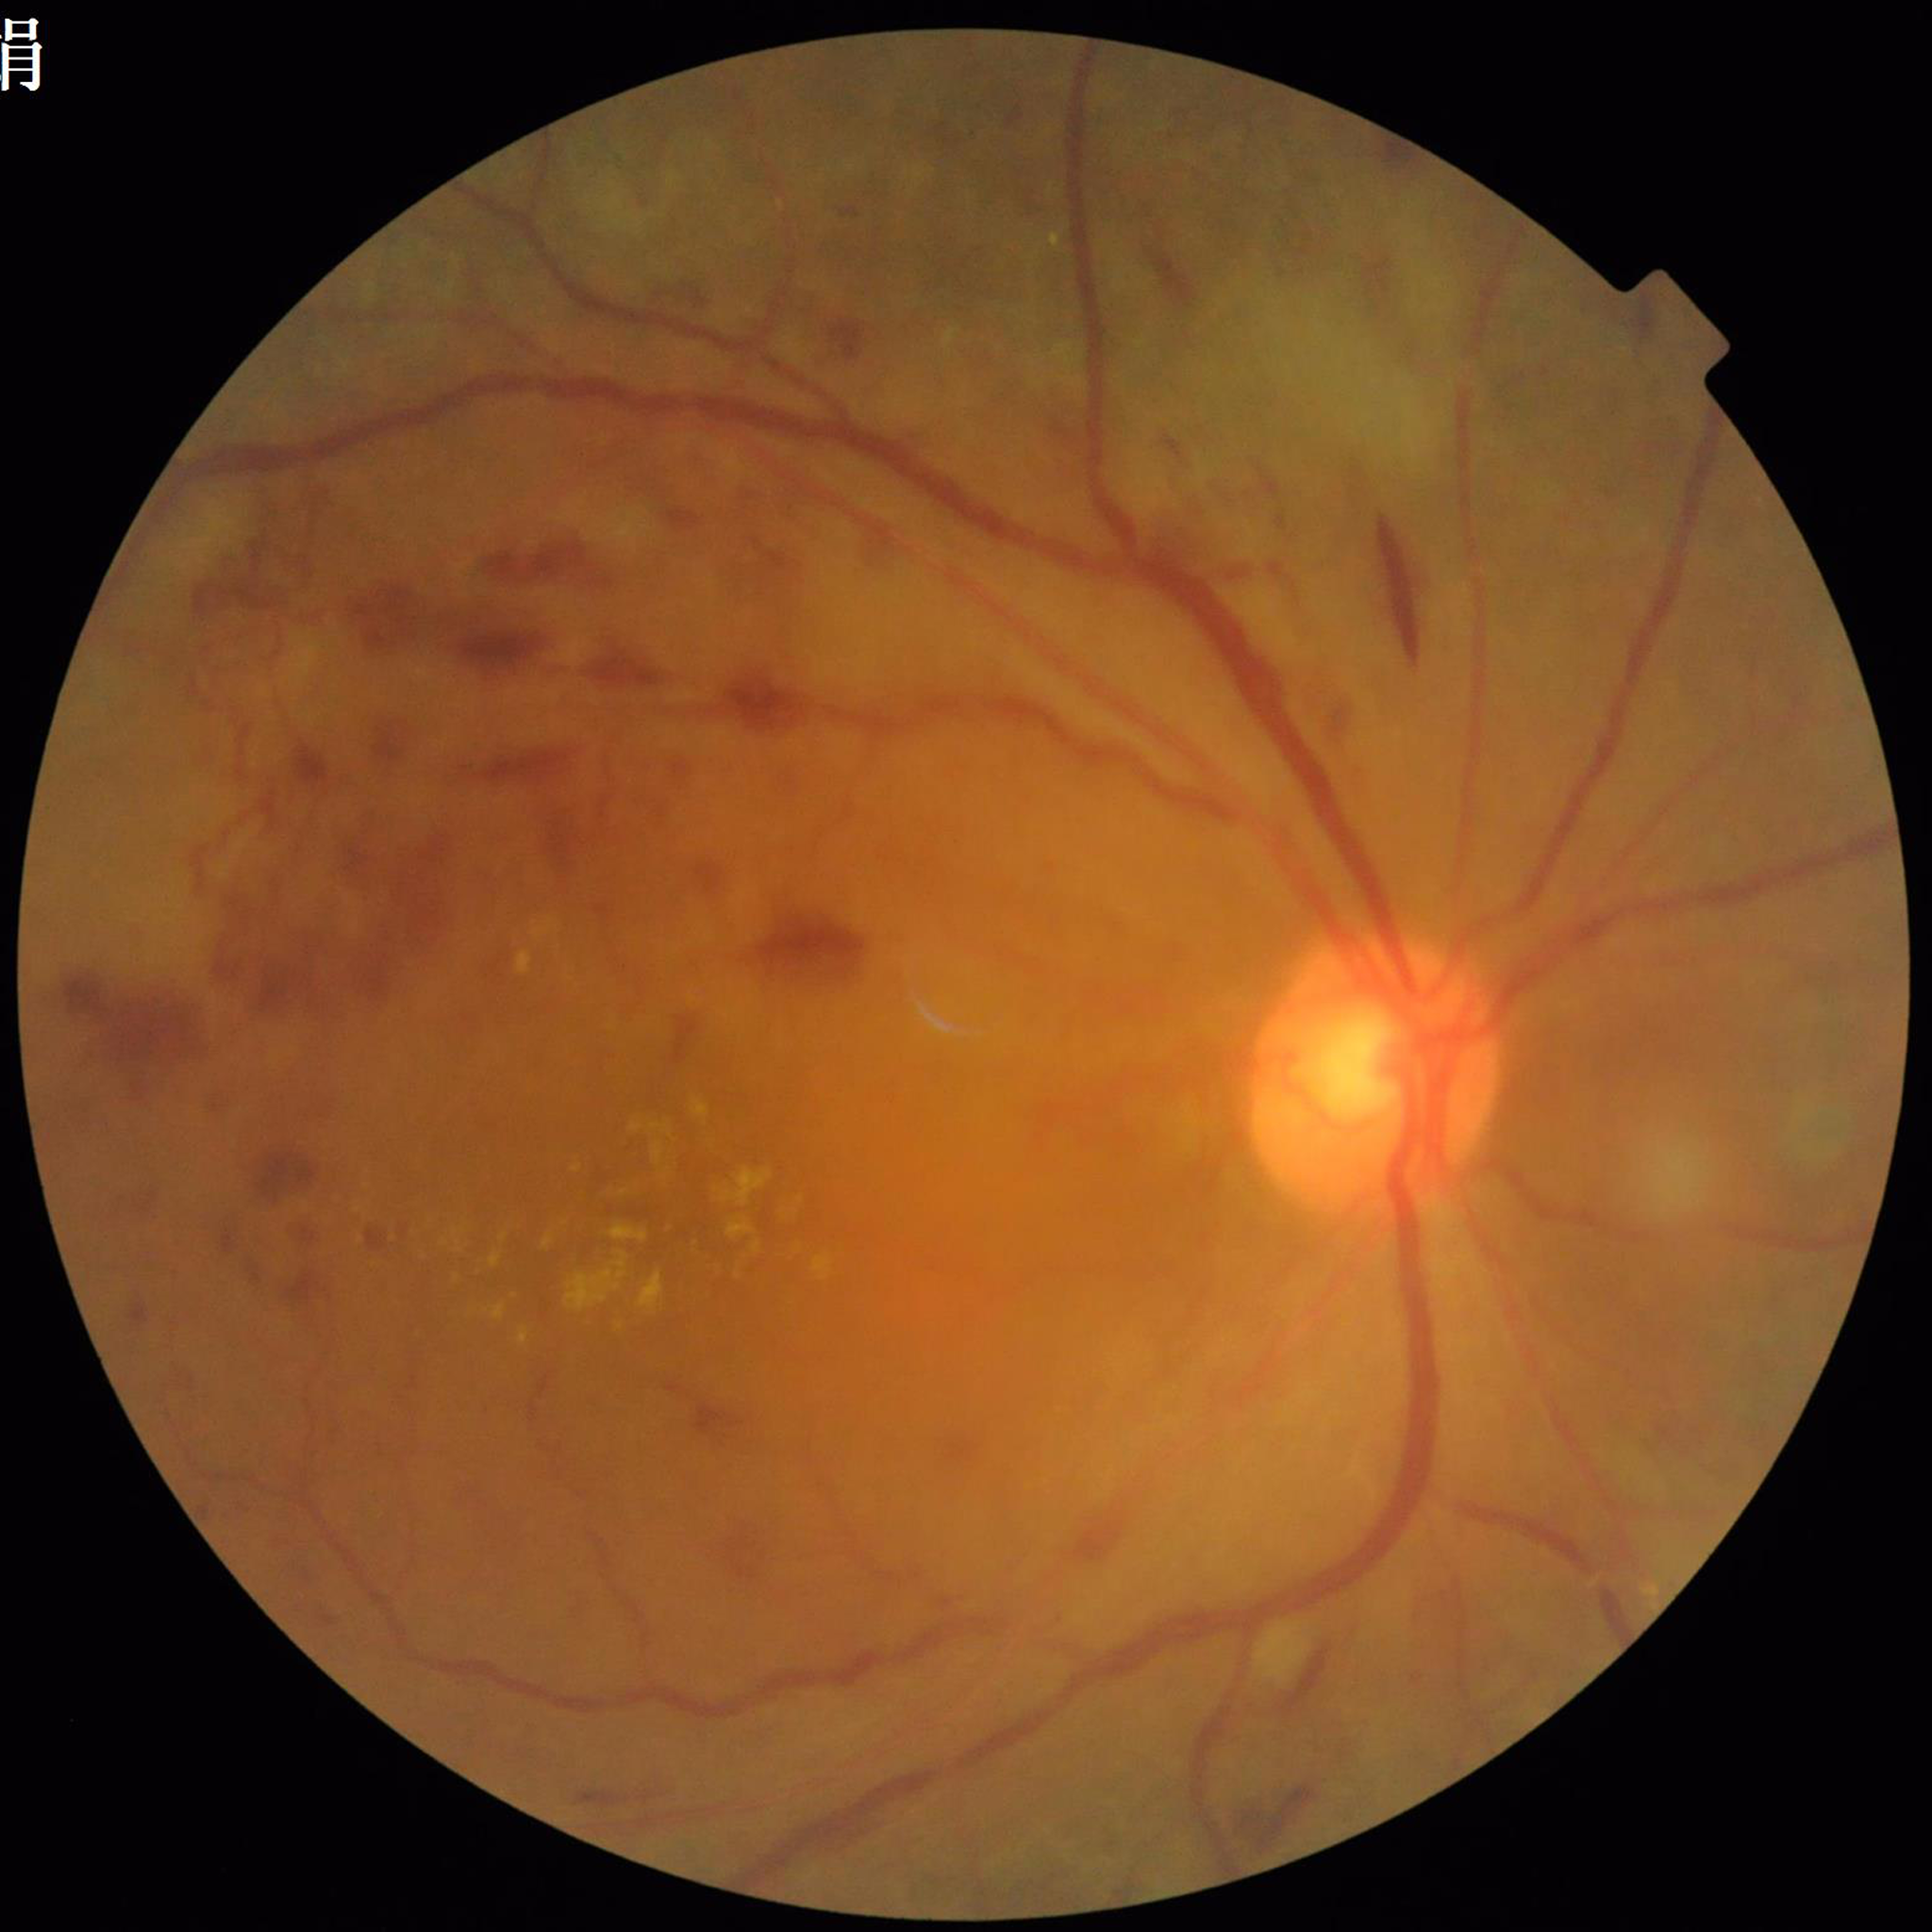 Disease class: DR.